Modified Davis grading
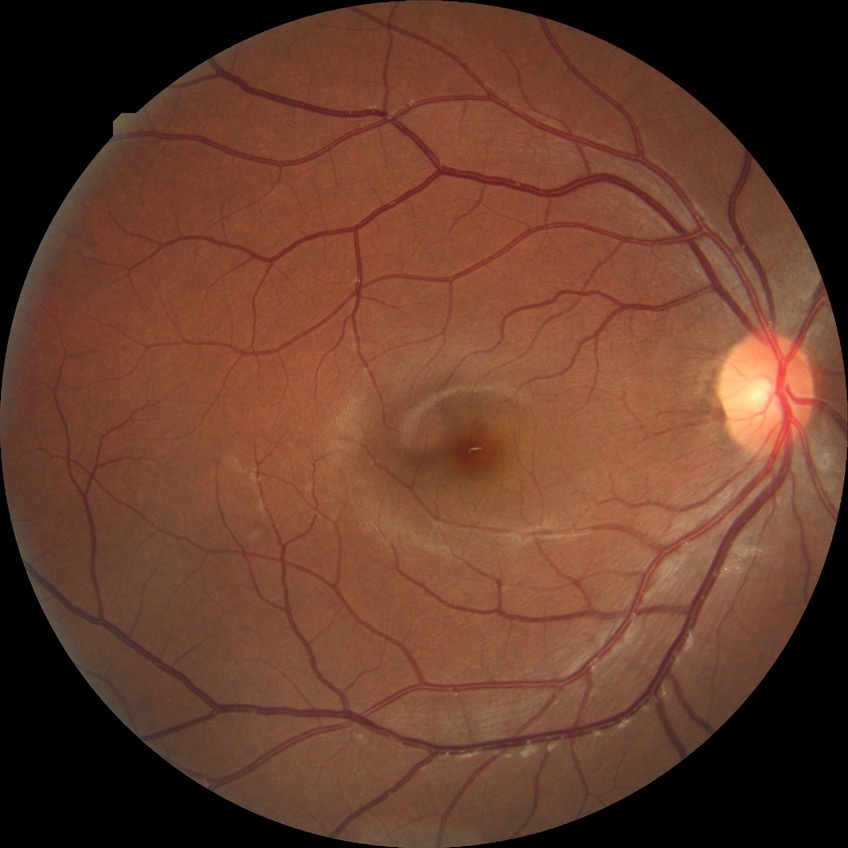 Diabetic retinopathy (DR): no diabetic retinopathy (NDR).